130° field of view (Clarity RetCam 3). Wide-field contact fundus photograph of an infant
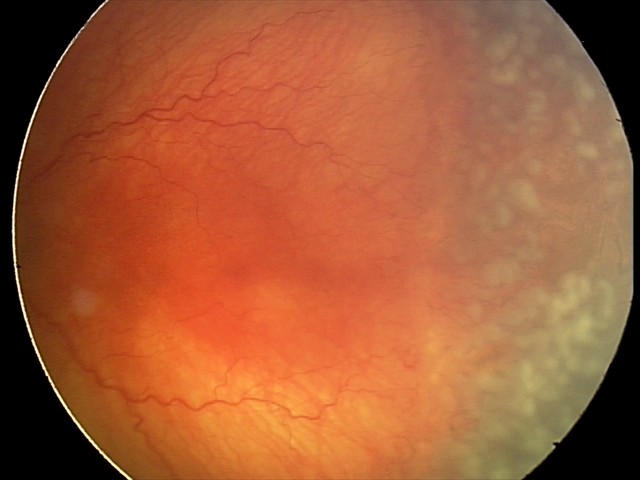 Plus form: present, diagnosis: aggressive retinopathy of prematurity (A-ROP) — rapidly progressive severe ROP with prominent plus disease, often without classic stage progression.